45° field of view. Color fundus image.
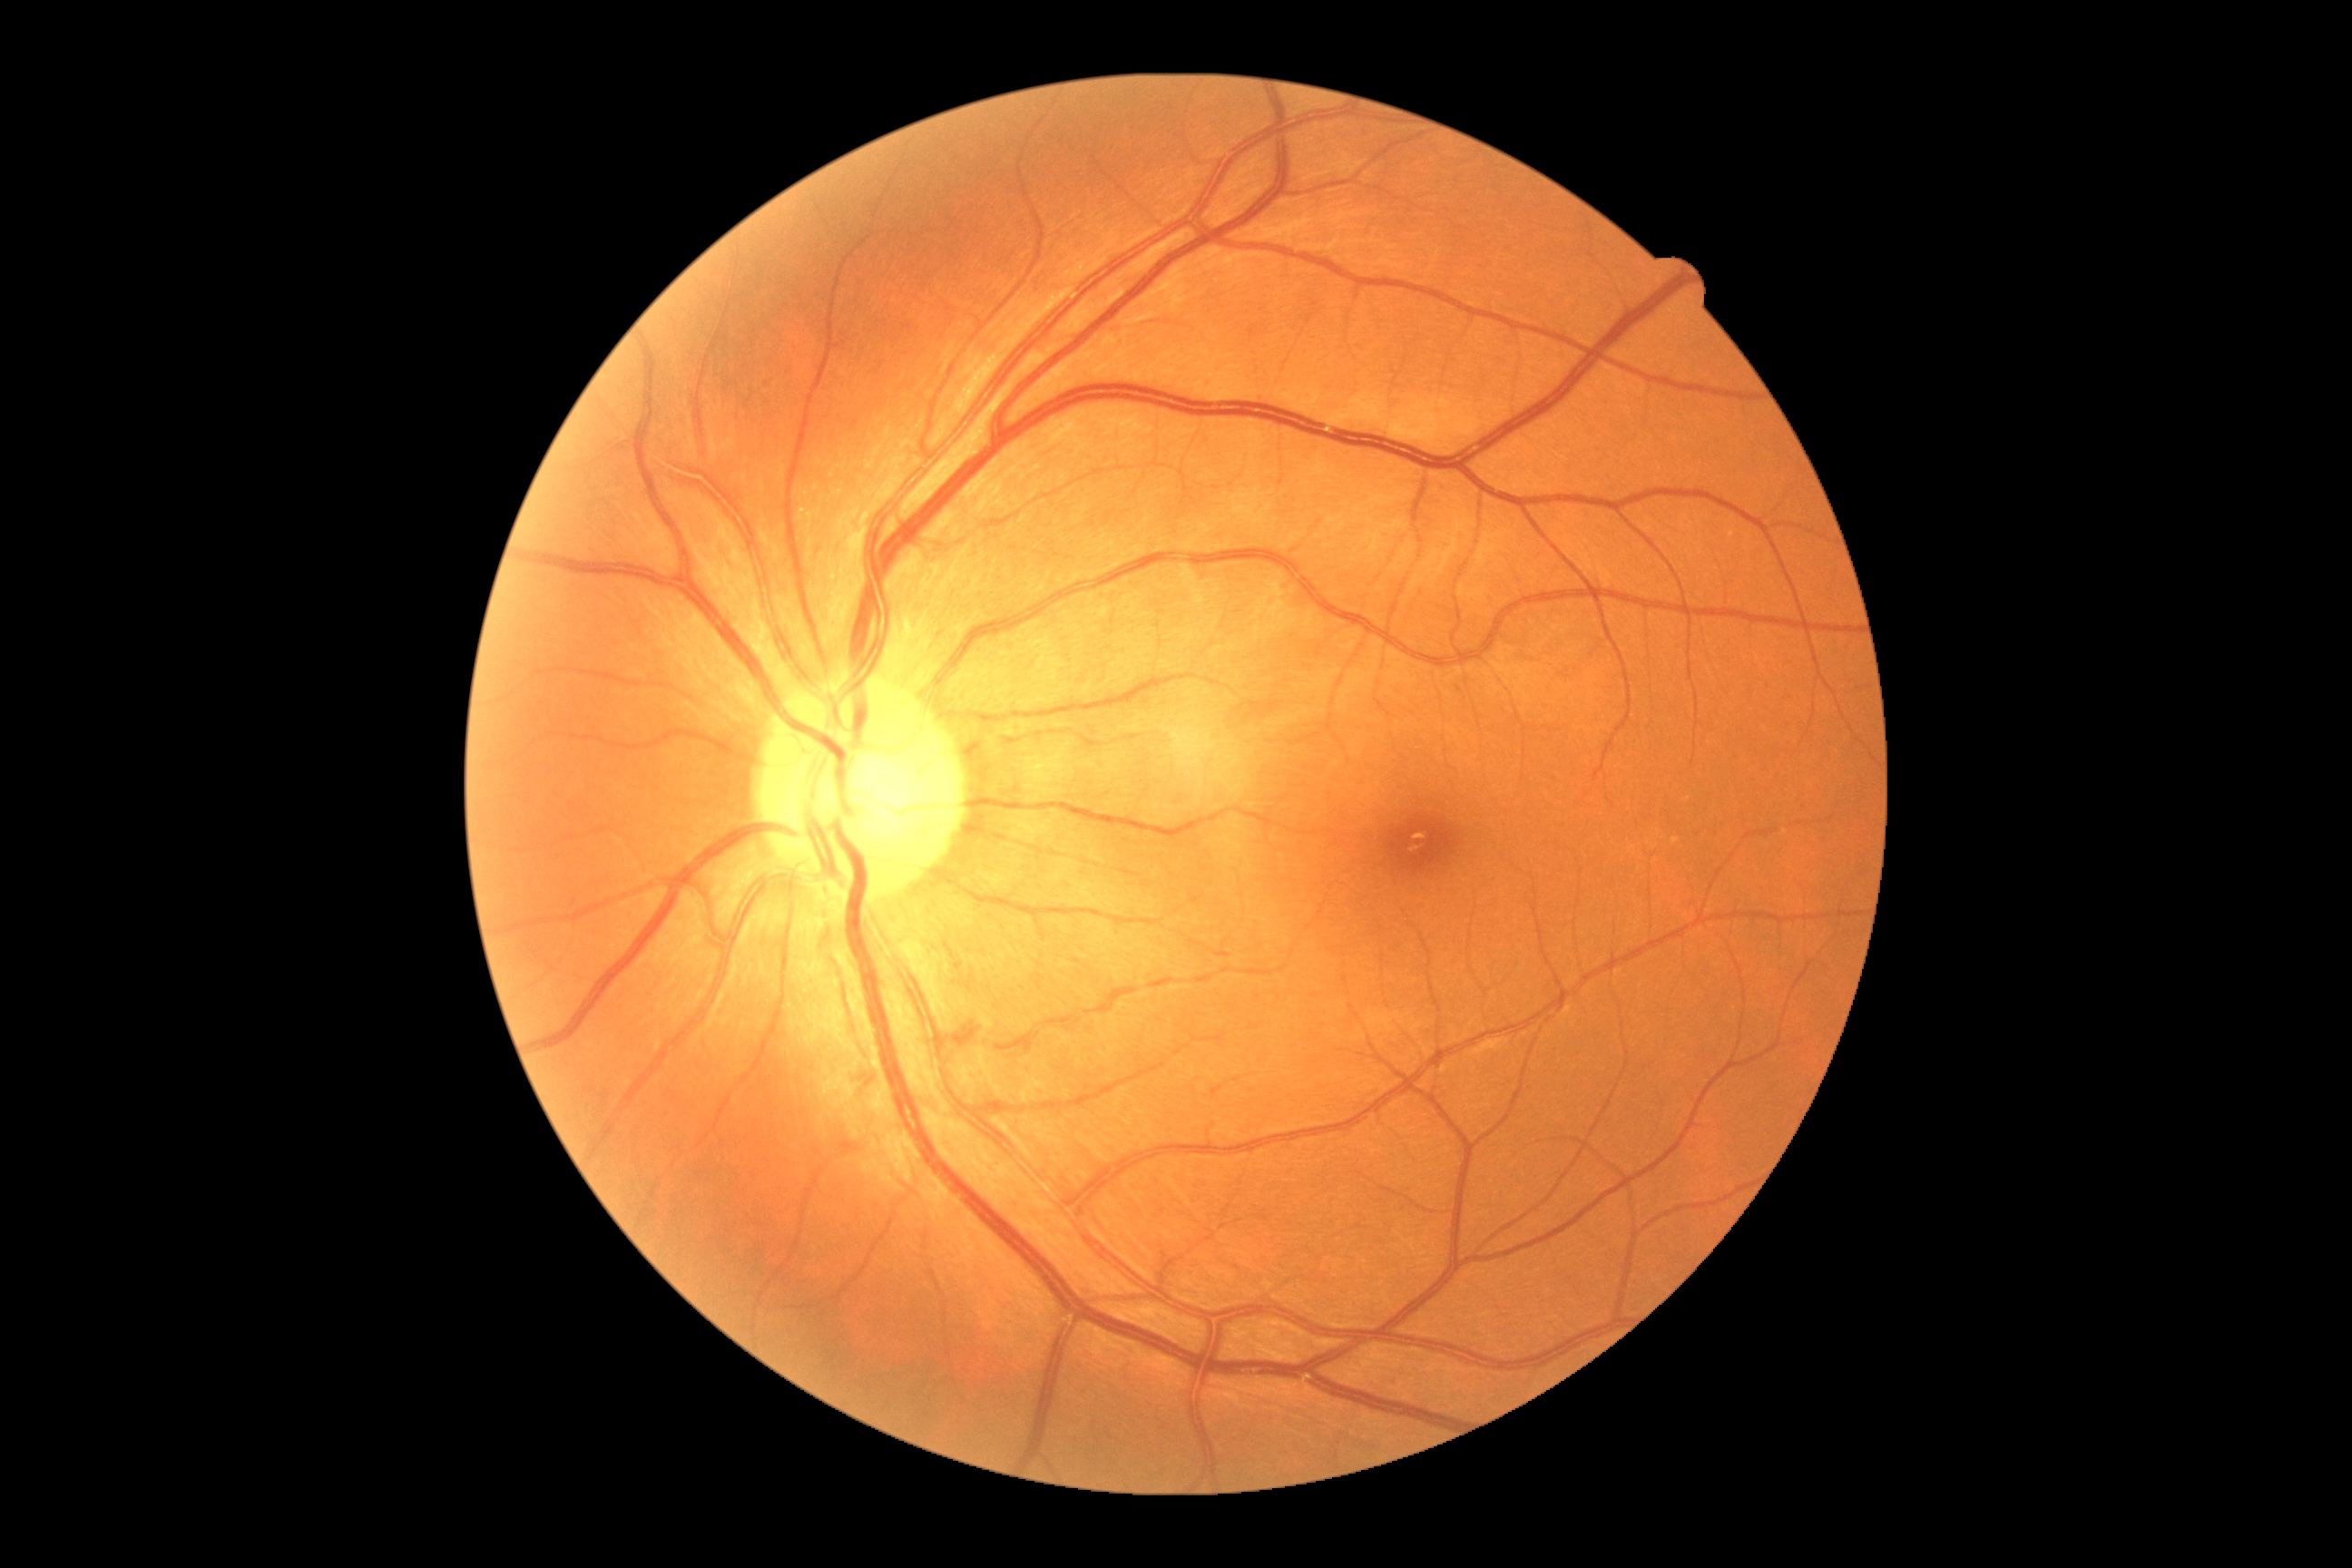 Diabetic retinopathy (DR): no apparent diabetic retinopathy (grade 0).